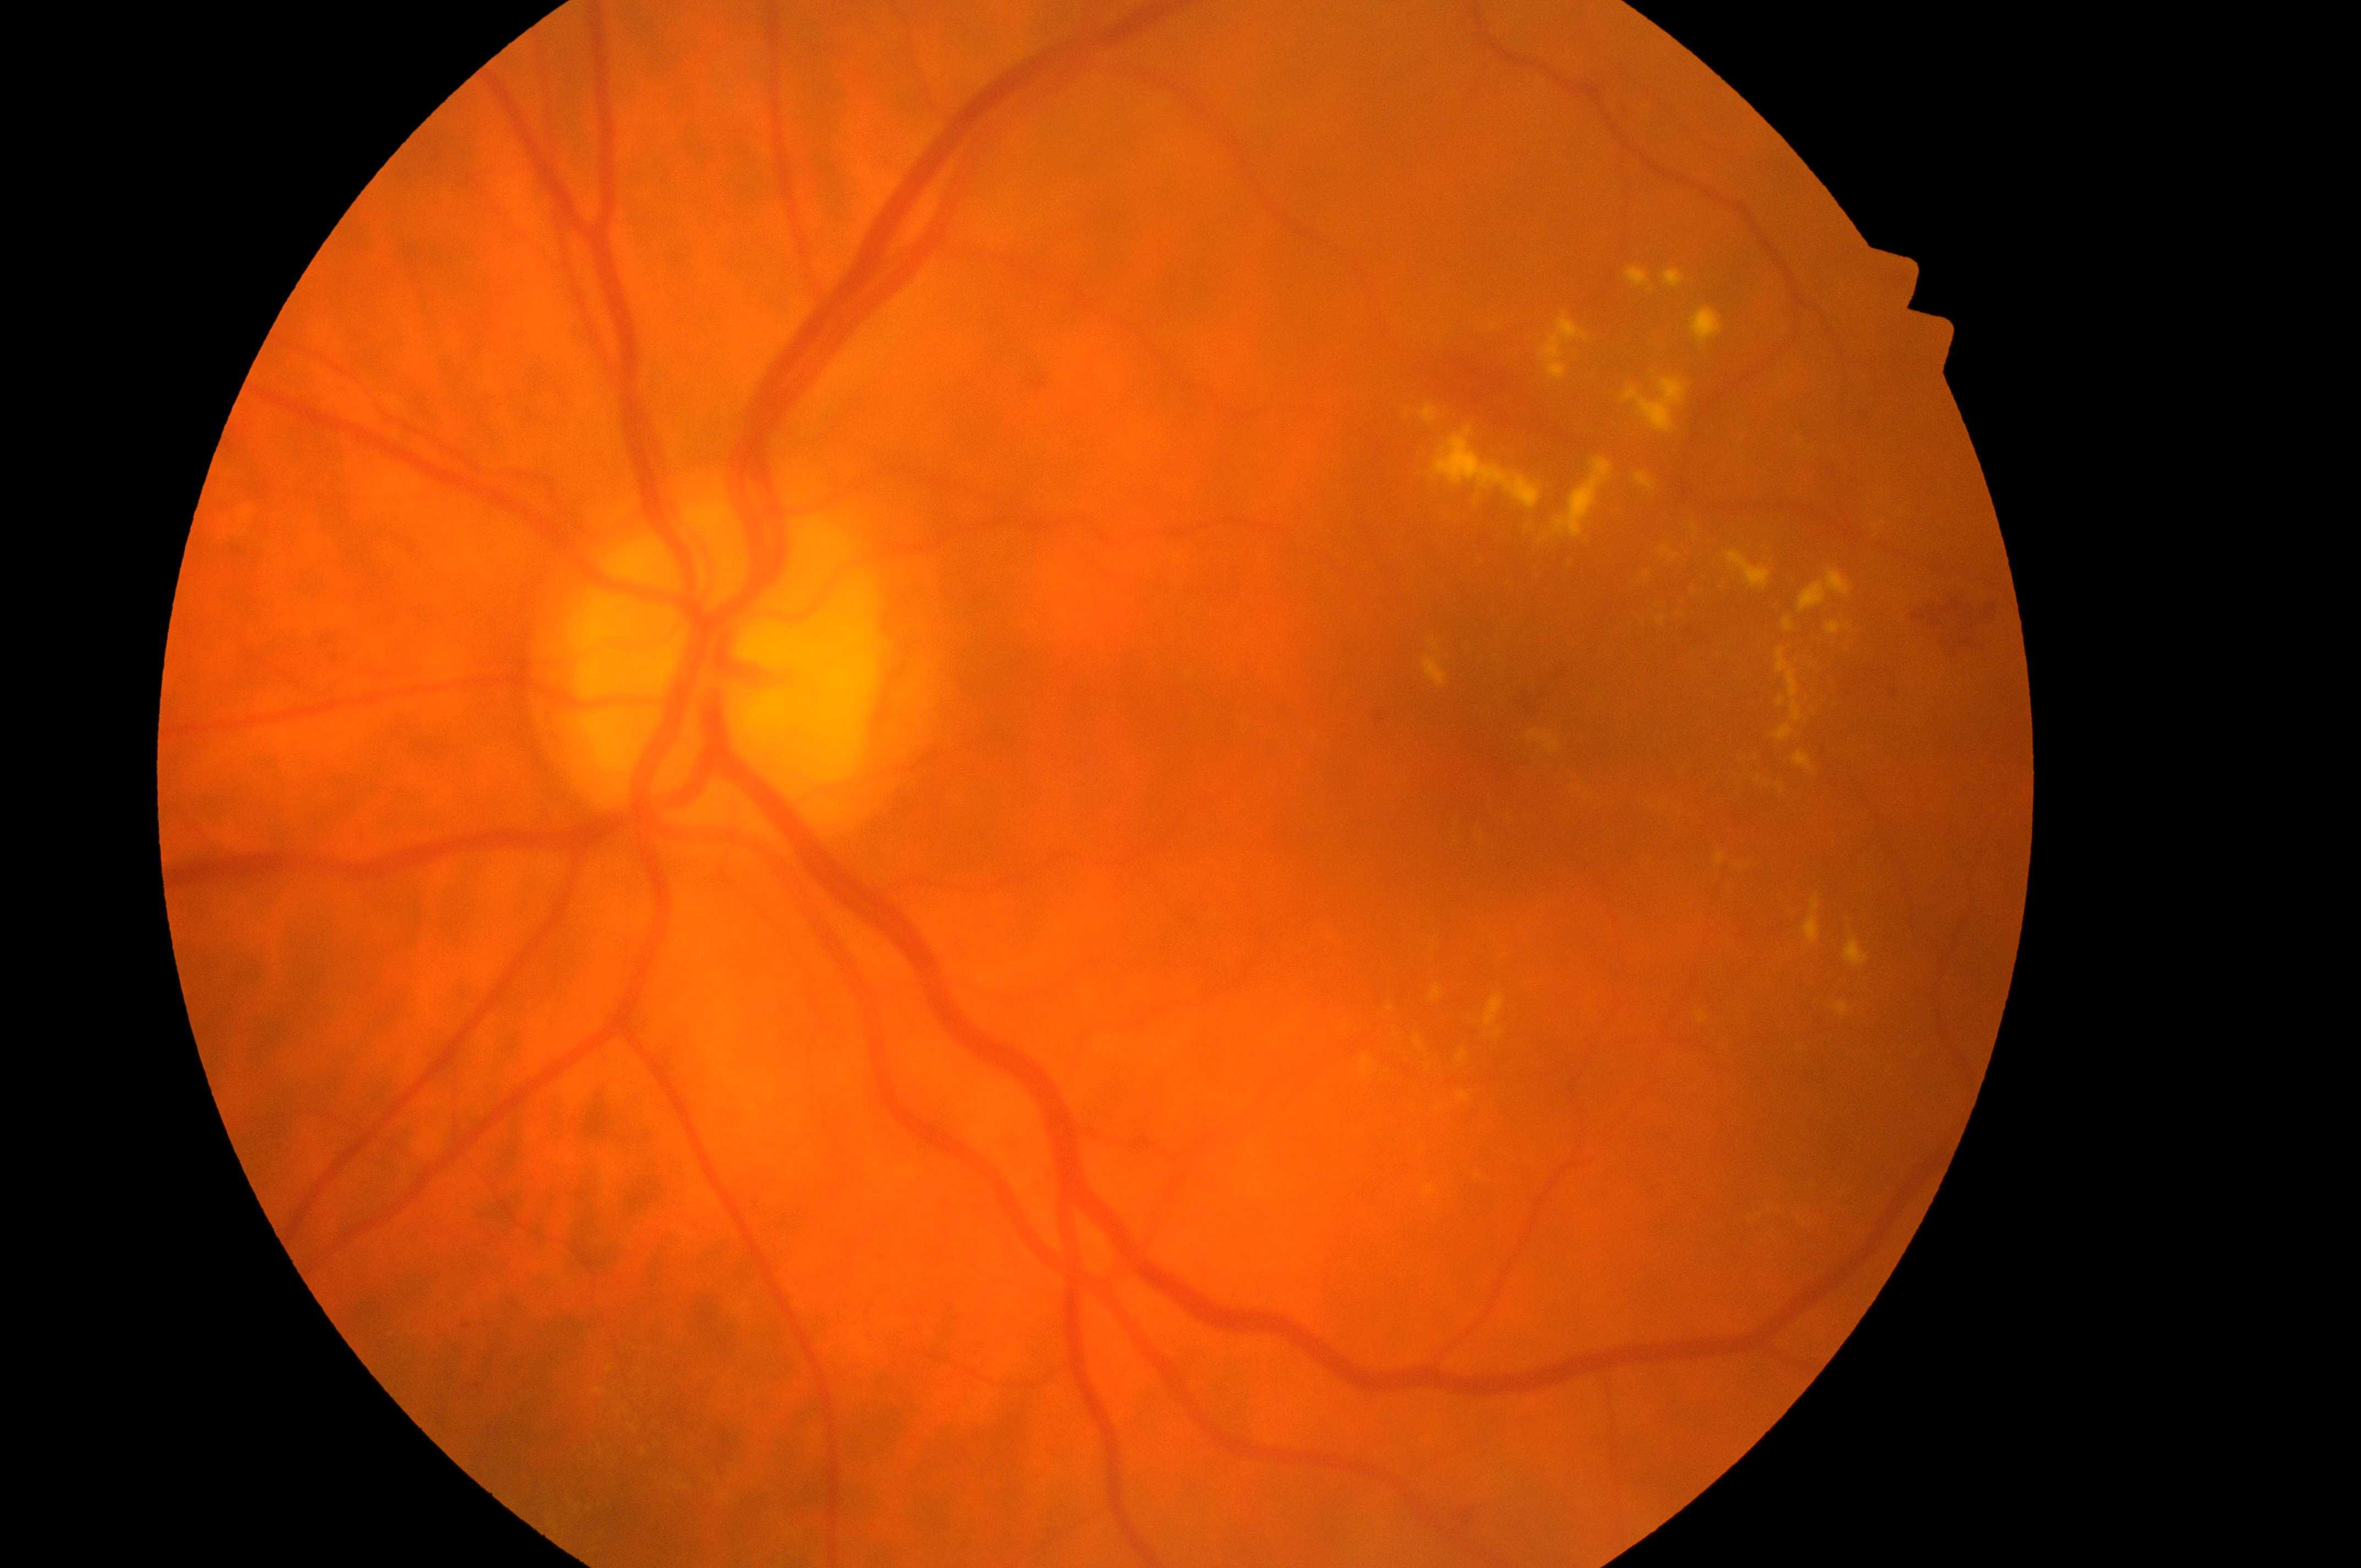 risk of diabetic macular edema: 2 | fovea center: 1528px, 726px | diabetic retinopathy grade: 2 | laterality: oculus sinister | the optic disc: 728px, 662px.